1440 x 1080 pixels. Pediatric wide-field fundus photograph. Acquired on the Natus RetCam Envision:
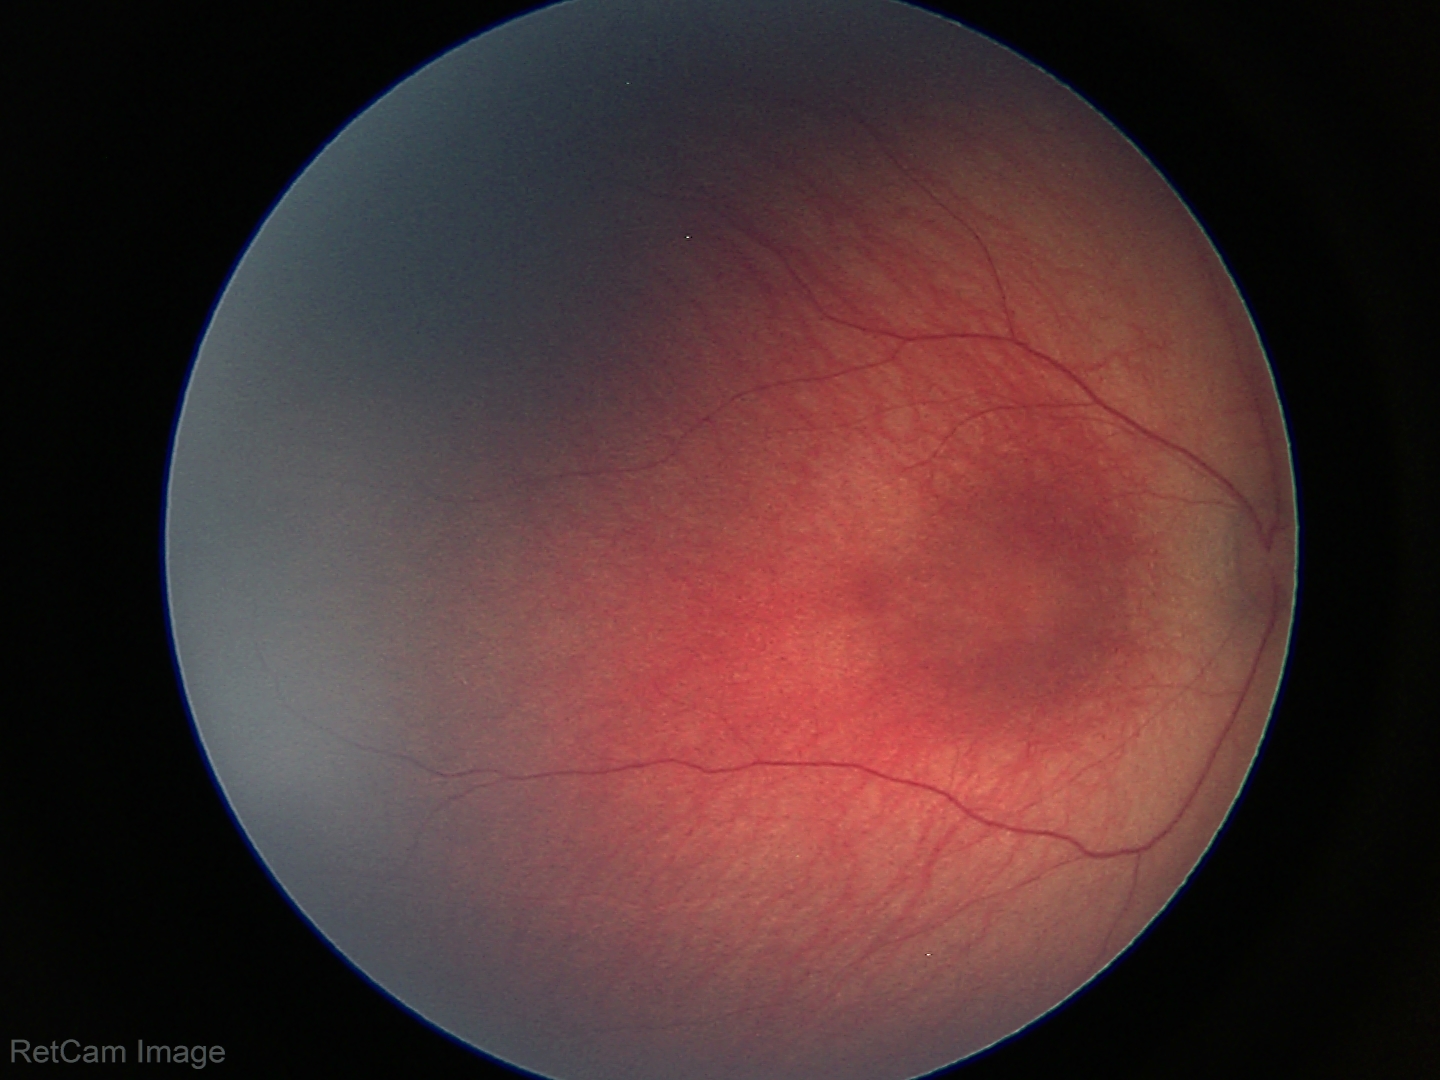
Normal screening examination.